Macula-centered:
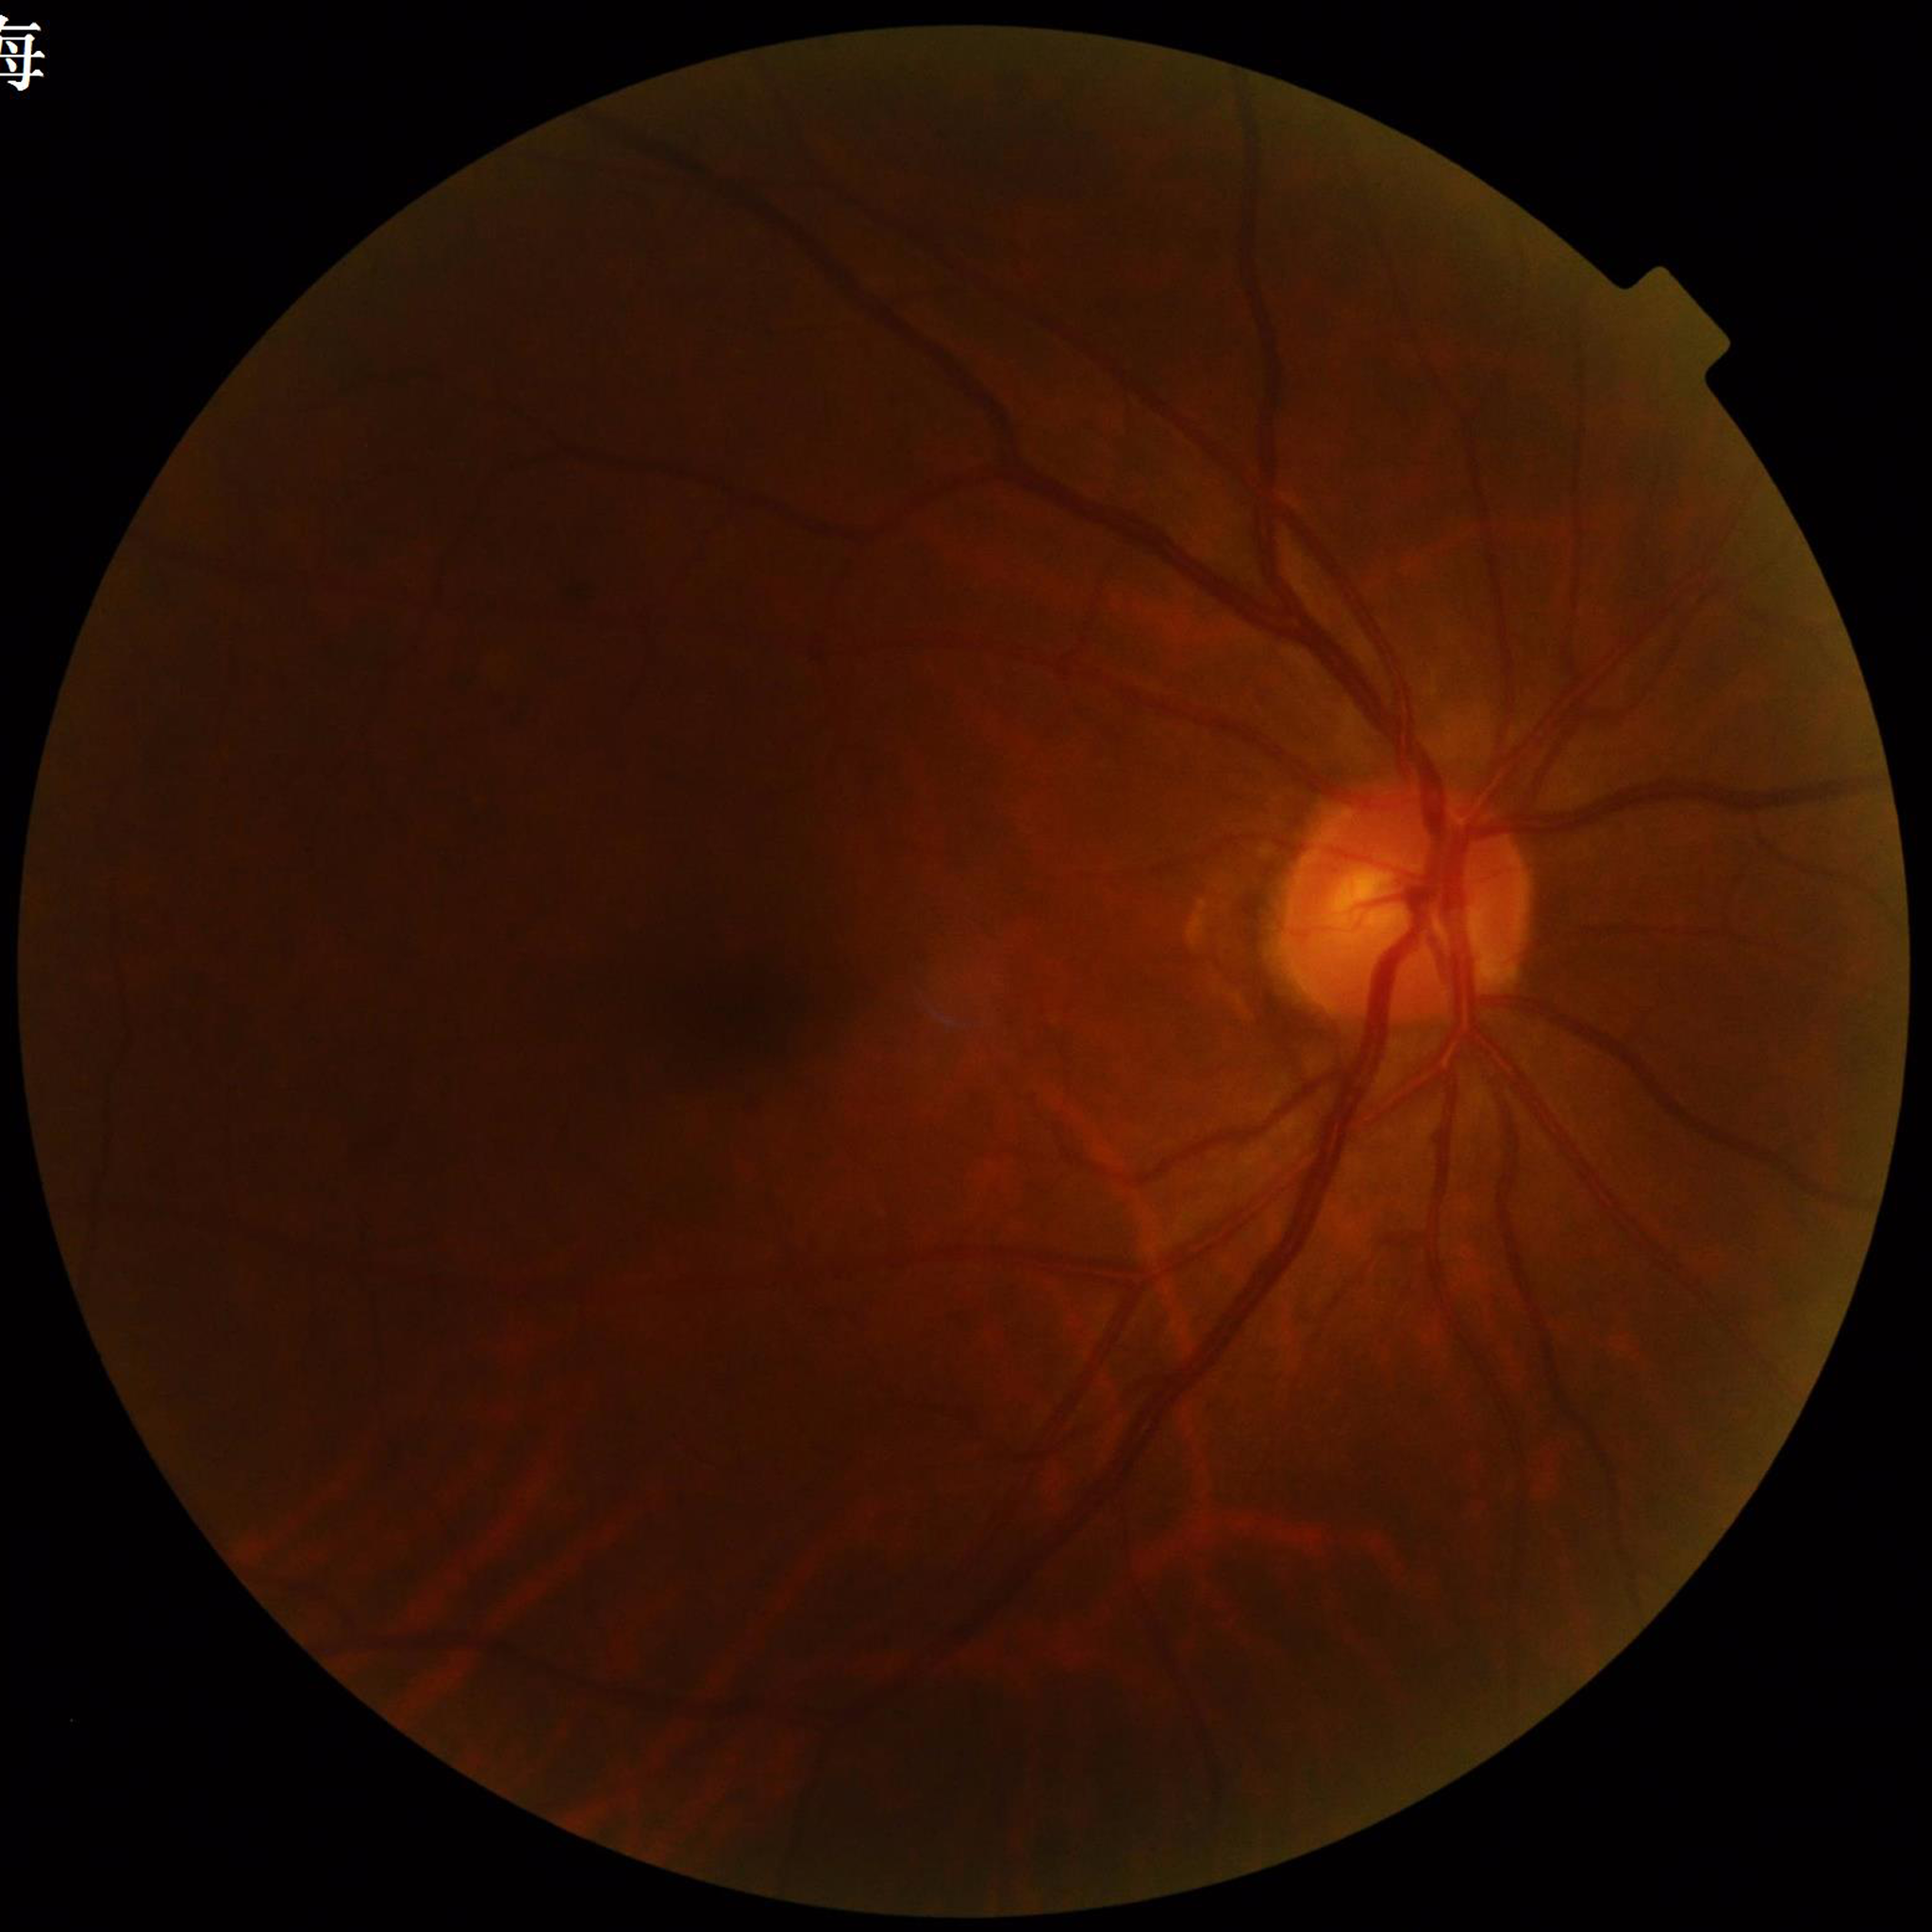 Color fundus photograph from a patient diagnosed with diabetic retinopathy (DR).